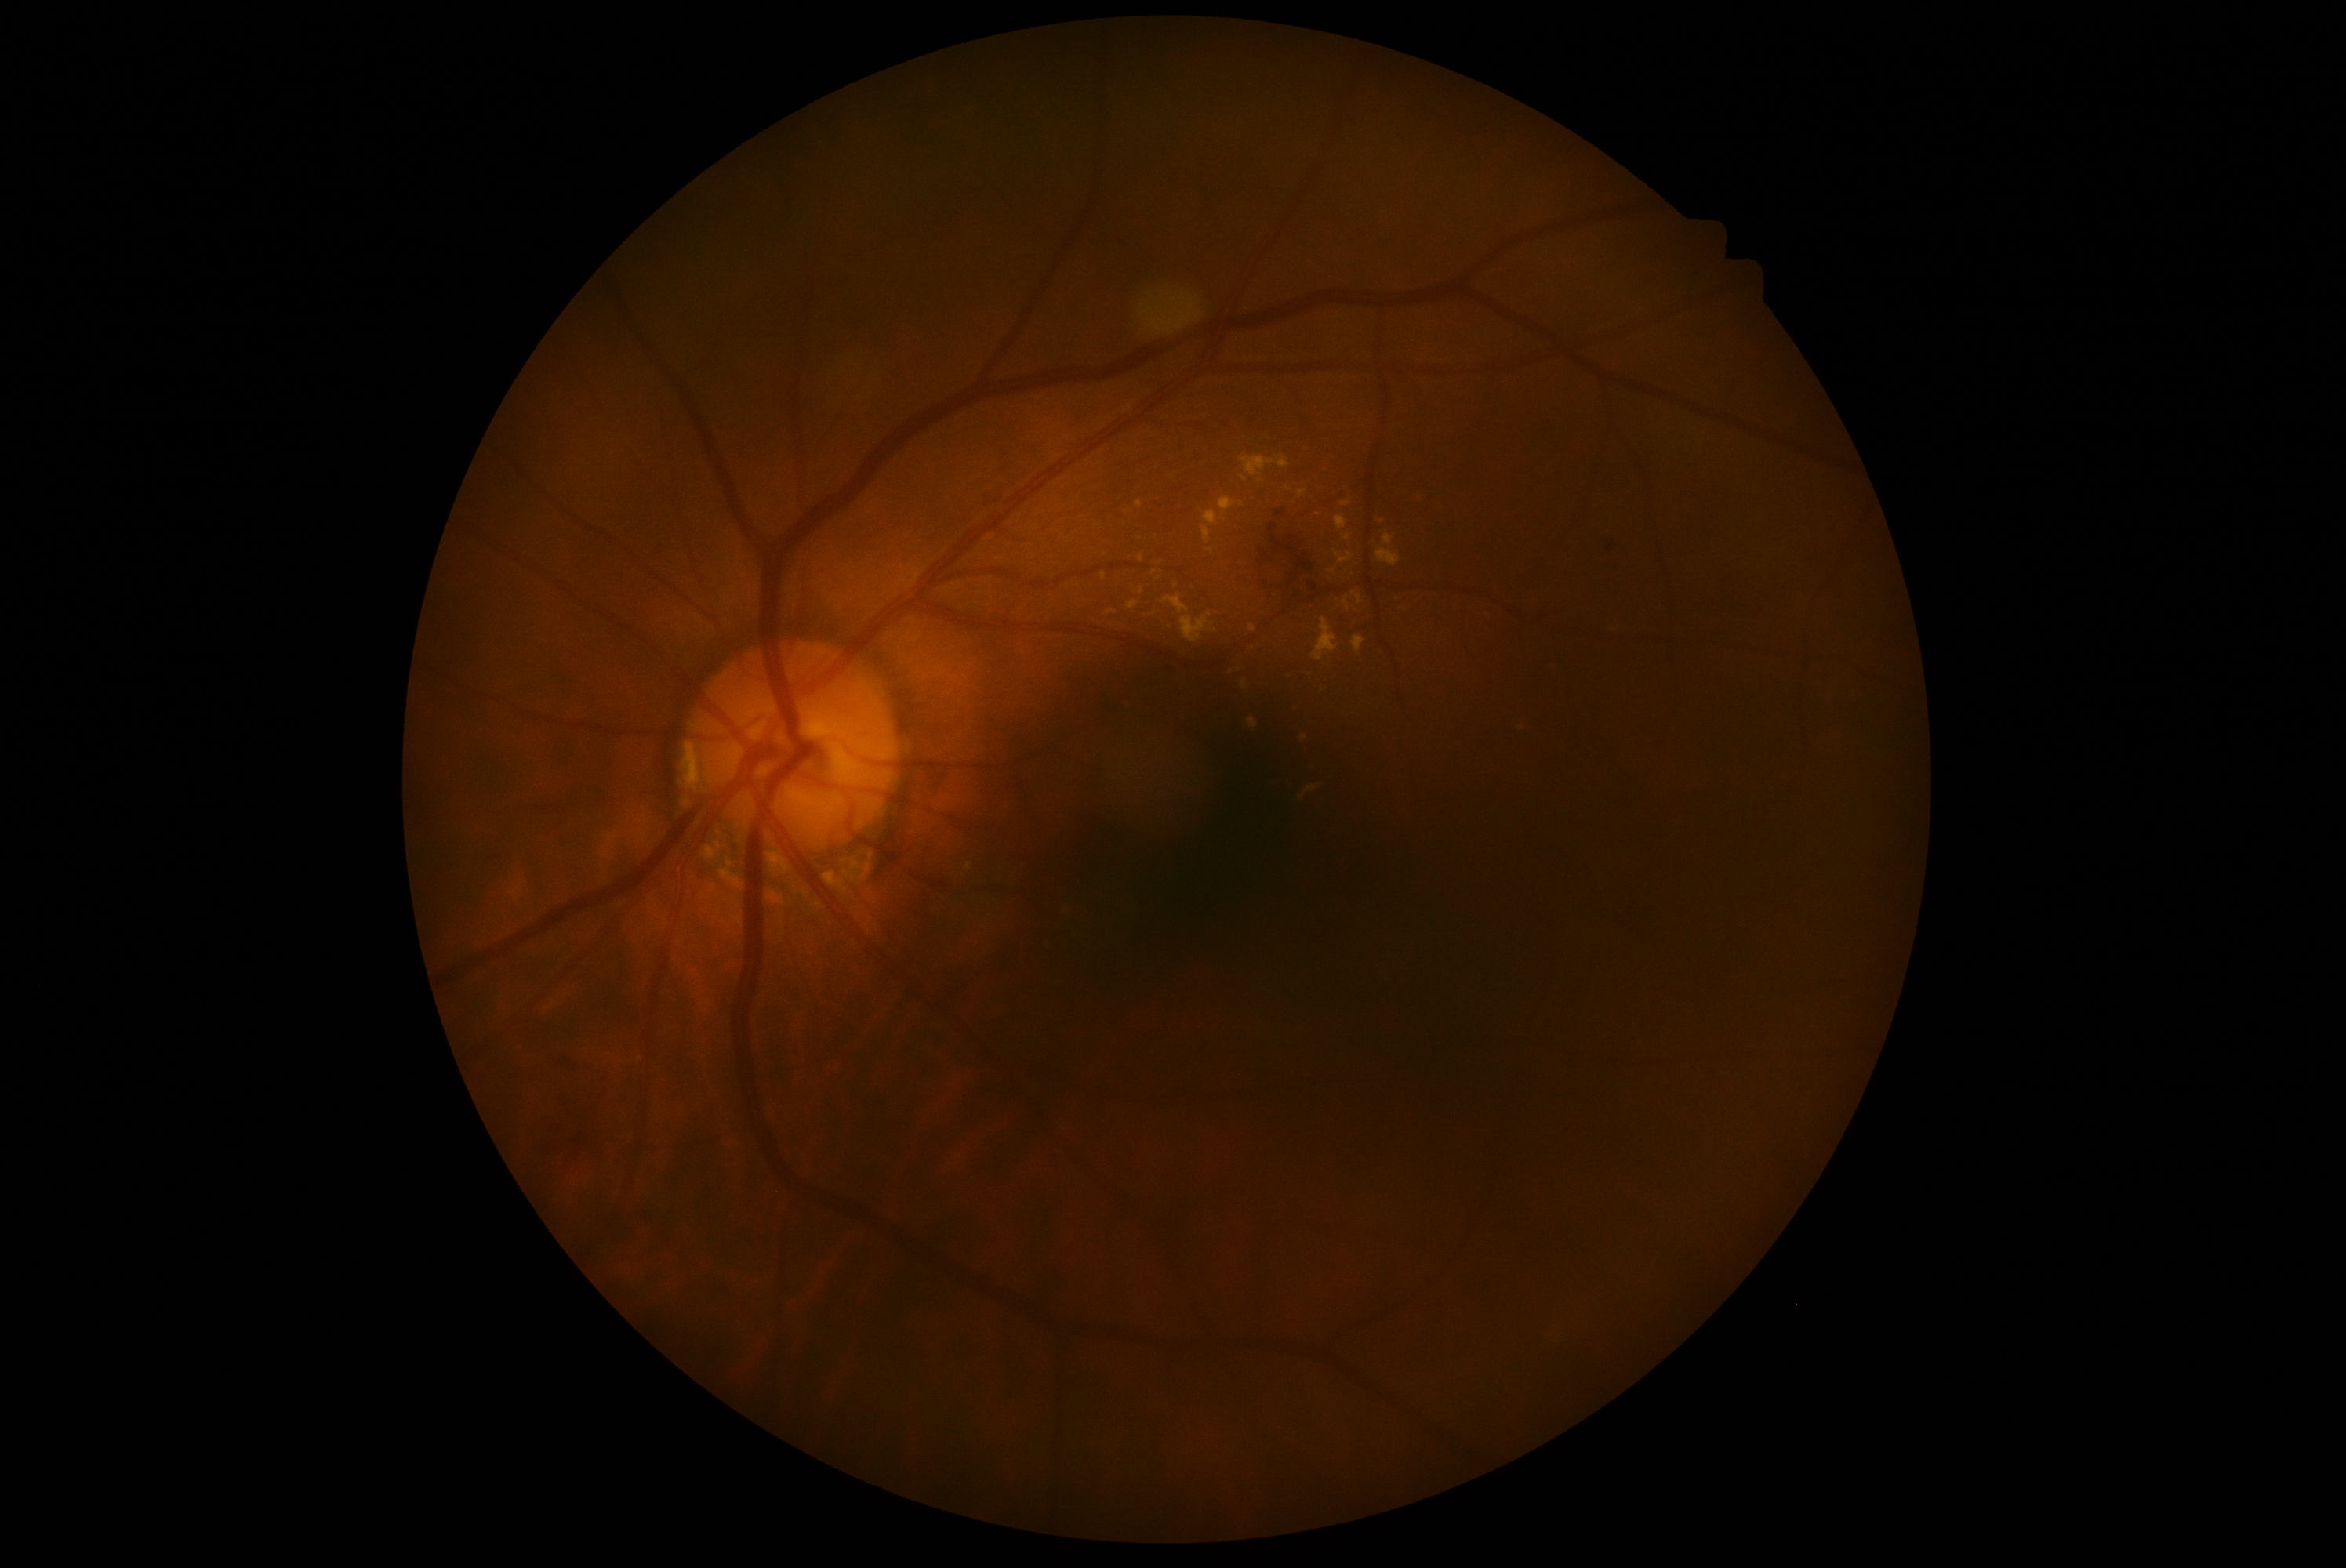

Retinopathy: grade 2 (moderate NPDR).